45° FOV, no pharmacologic dilation
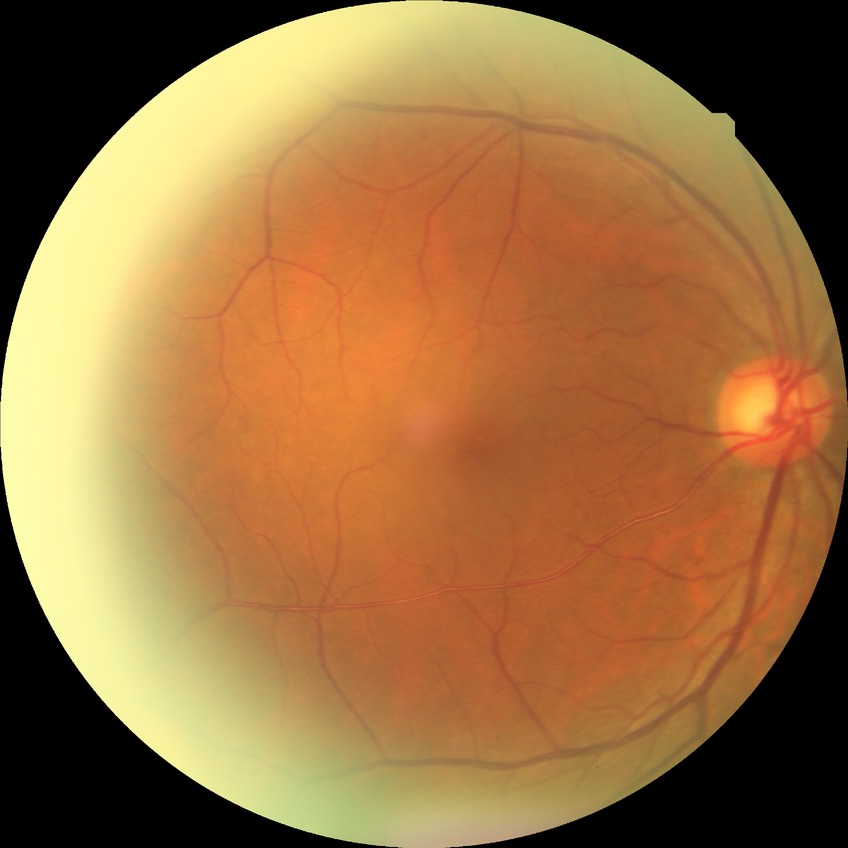 Retinopathy stage: no diabetic retinopathy.